Acquired on the Phoenix ICON · infant wide-field retinal image
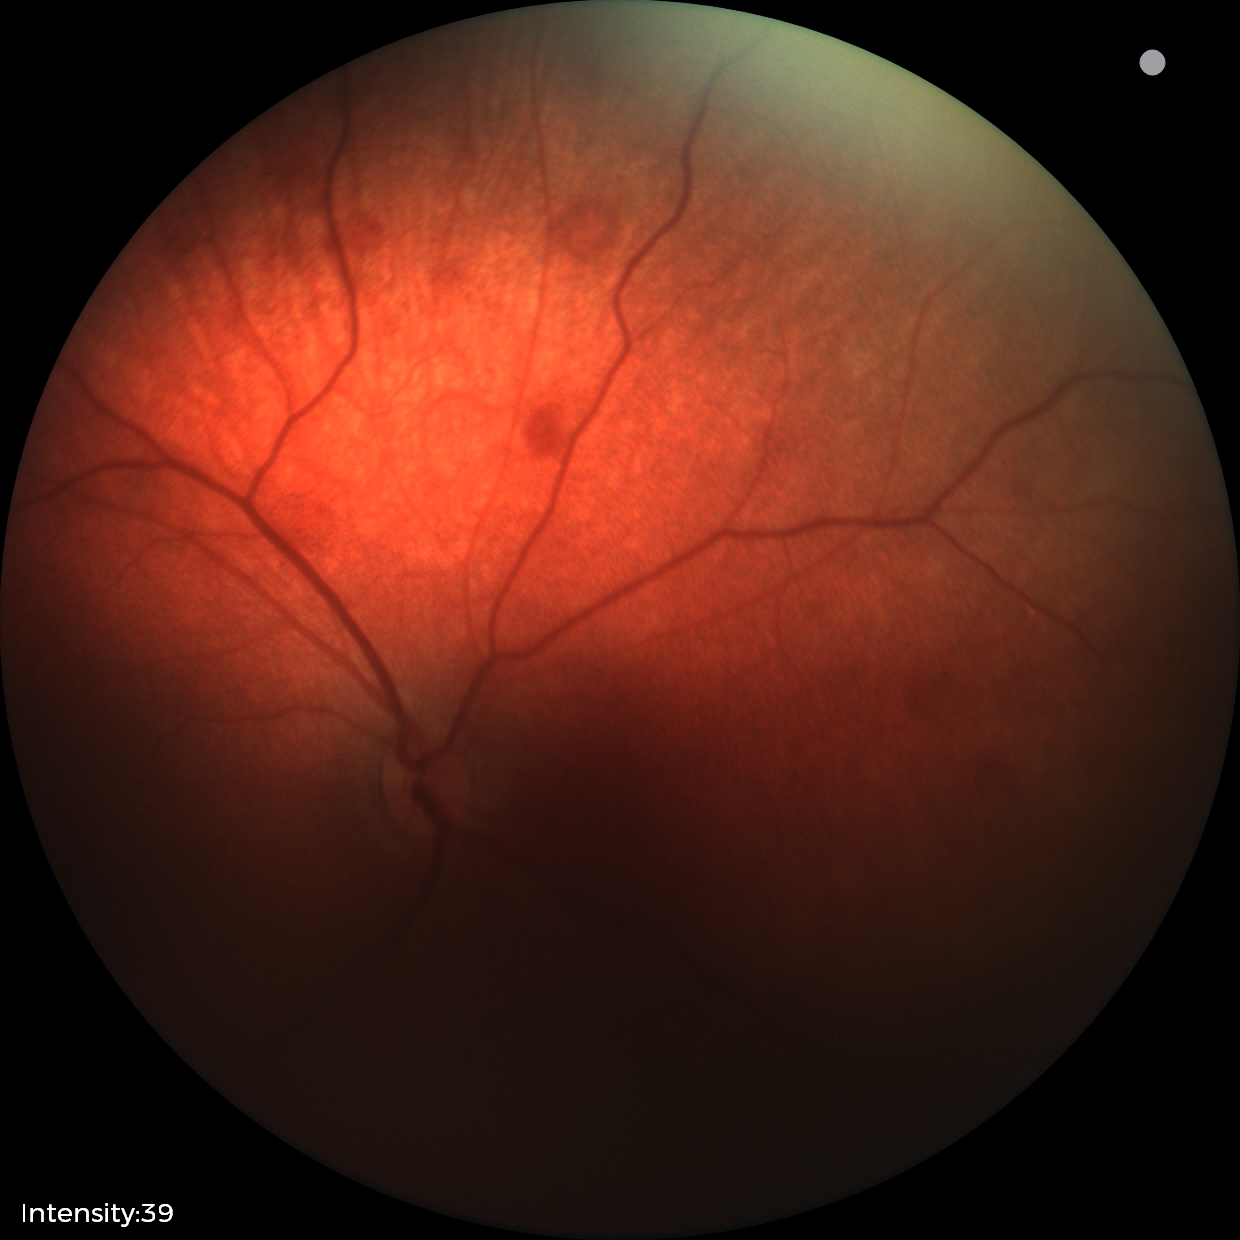 Diagnosis: retinal hemorrhages.